NIDEK AFC-230 fundus camera.
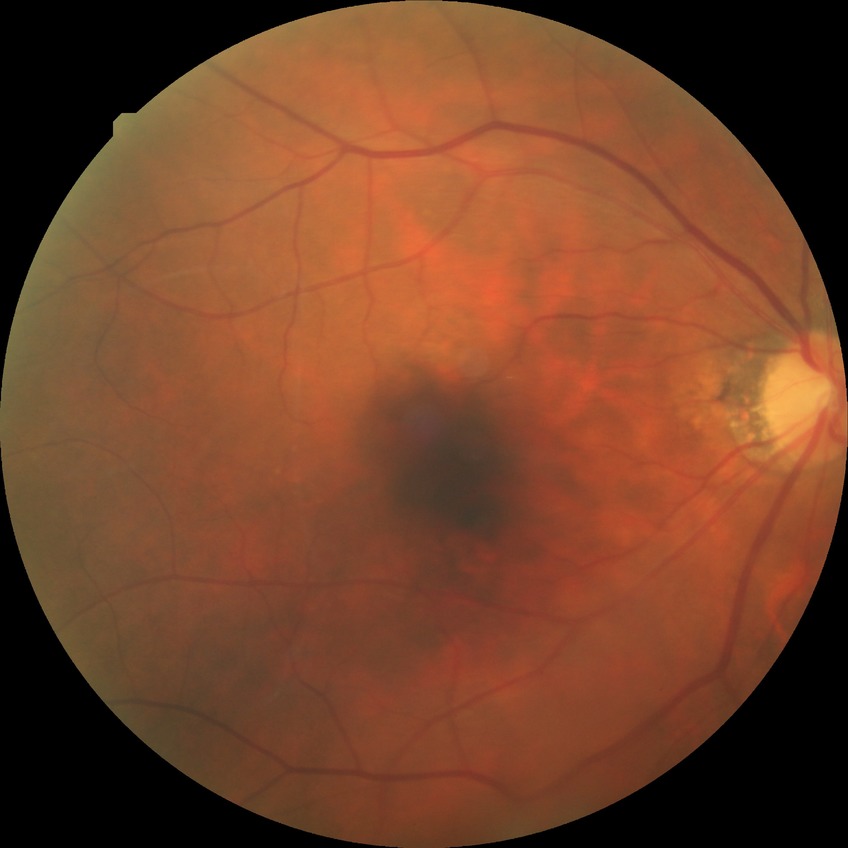

Diabetic retinopathy (DR) is no diabetic retinopathy (NDR).